45 degree fundus photograph — 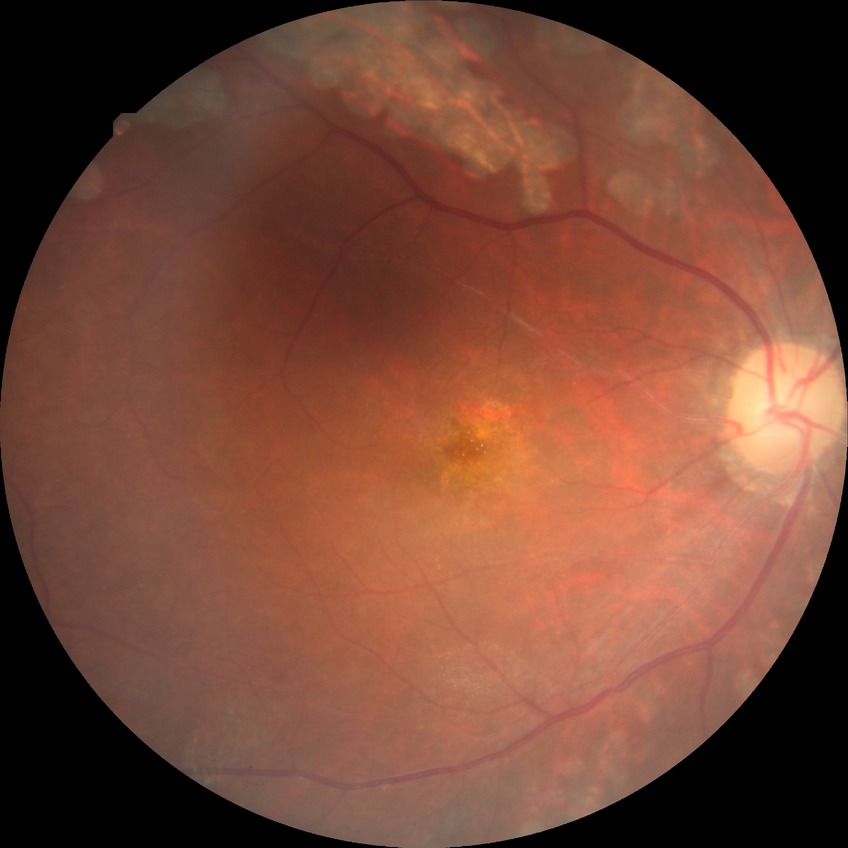 Retinopathy grade: proliferative diabetic retinopathy.